45 degree fundus photograph — 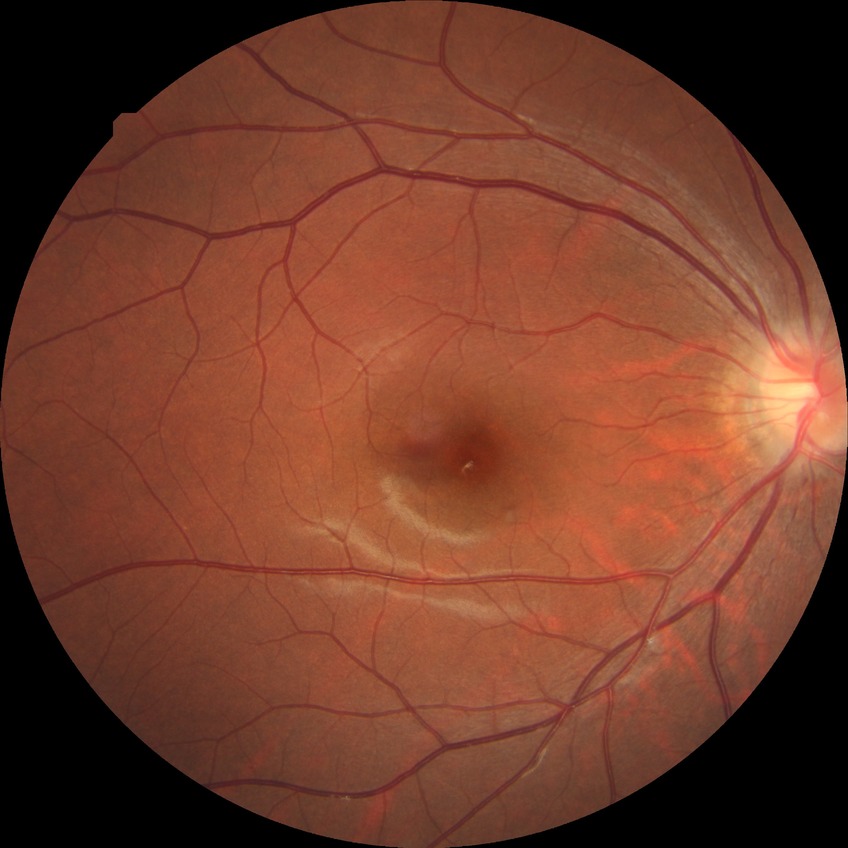

No DR findings. DR grade: NDR.